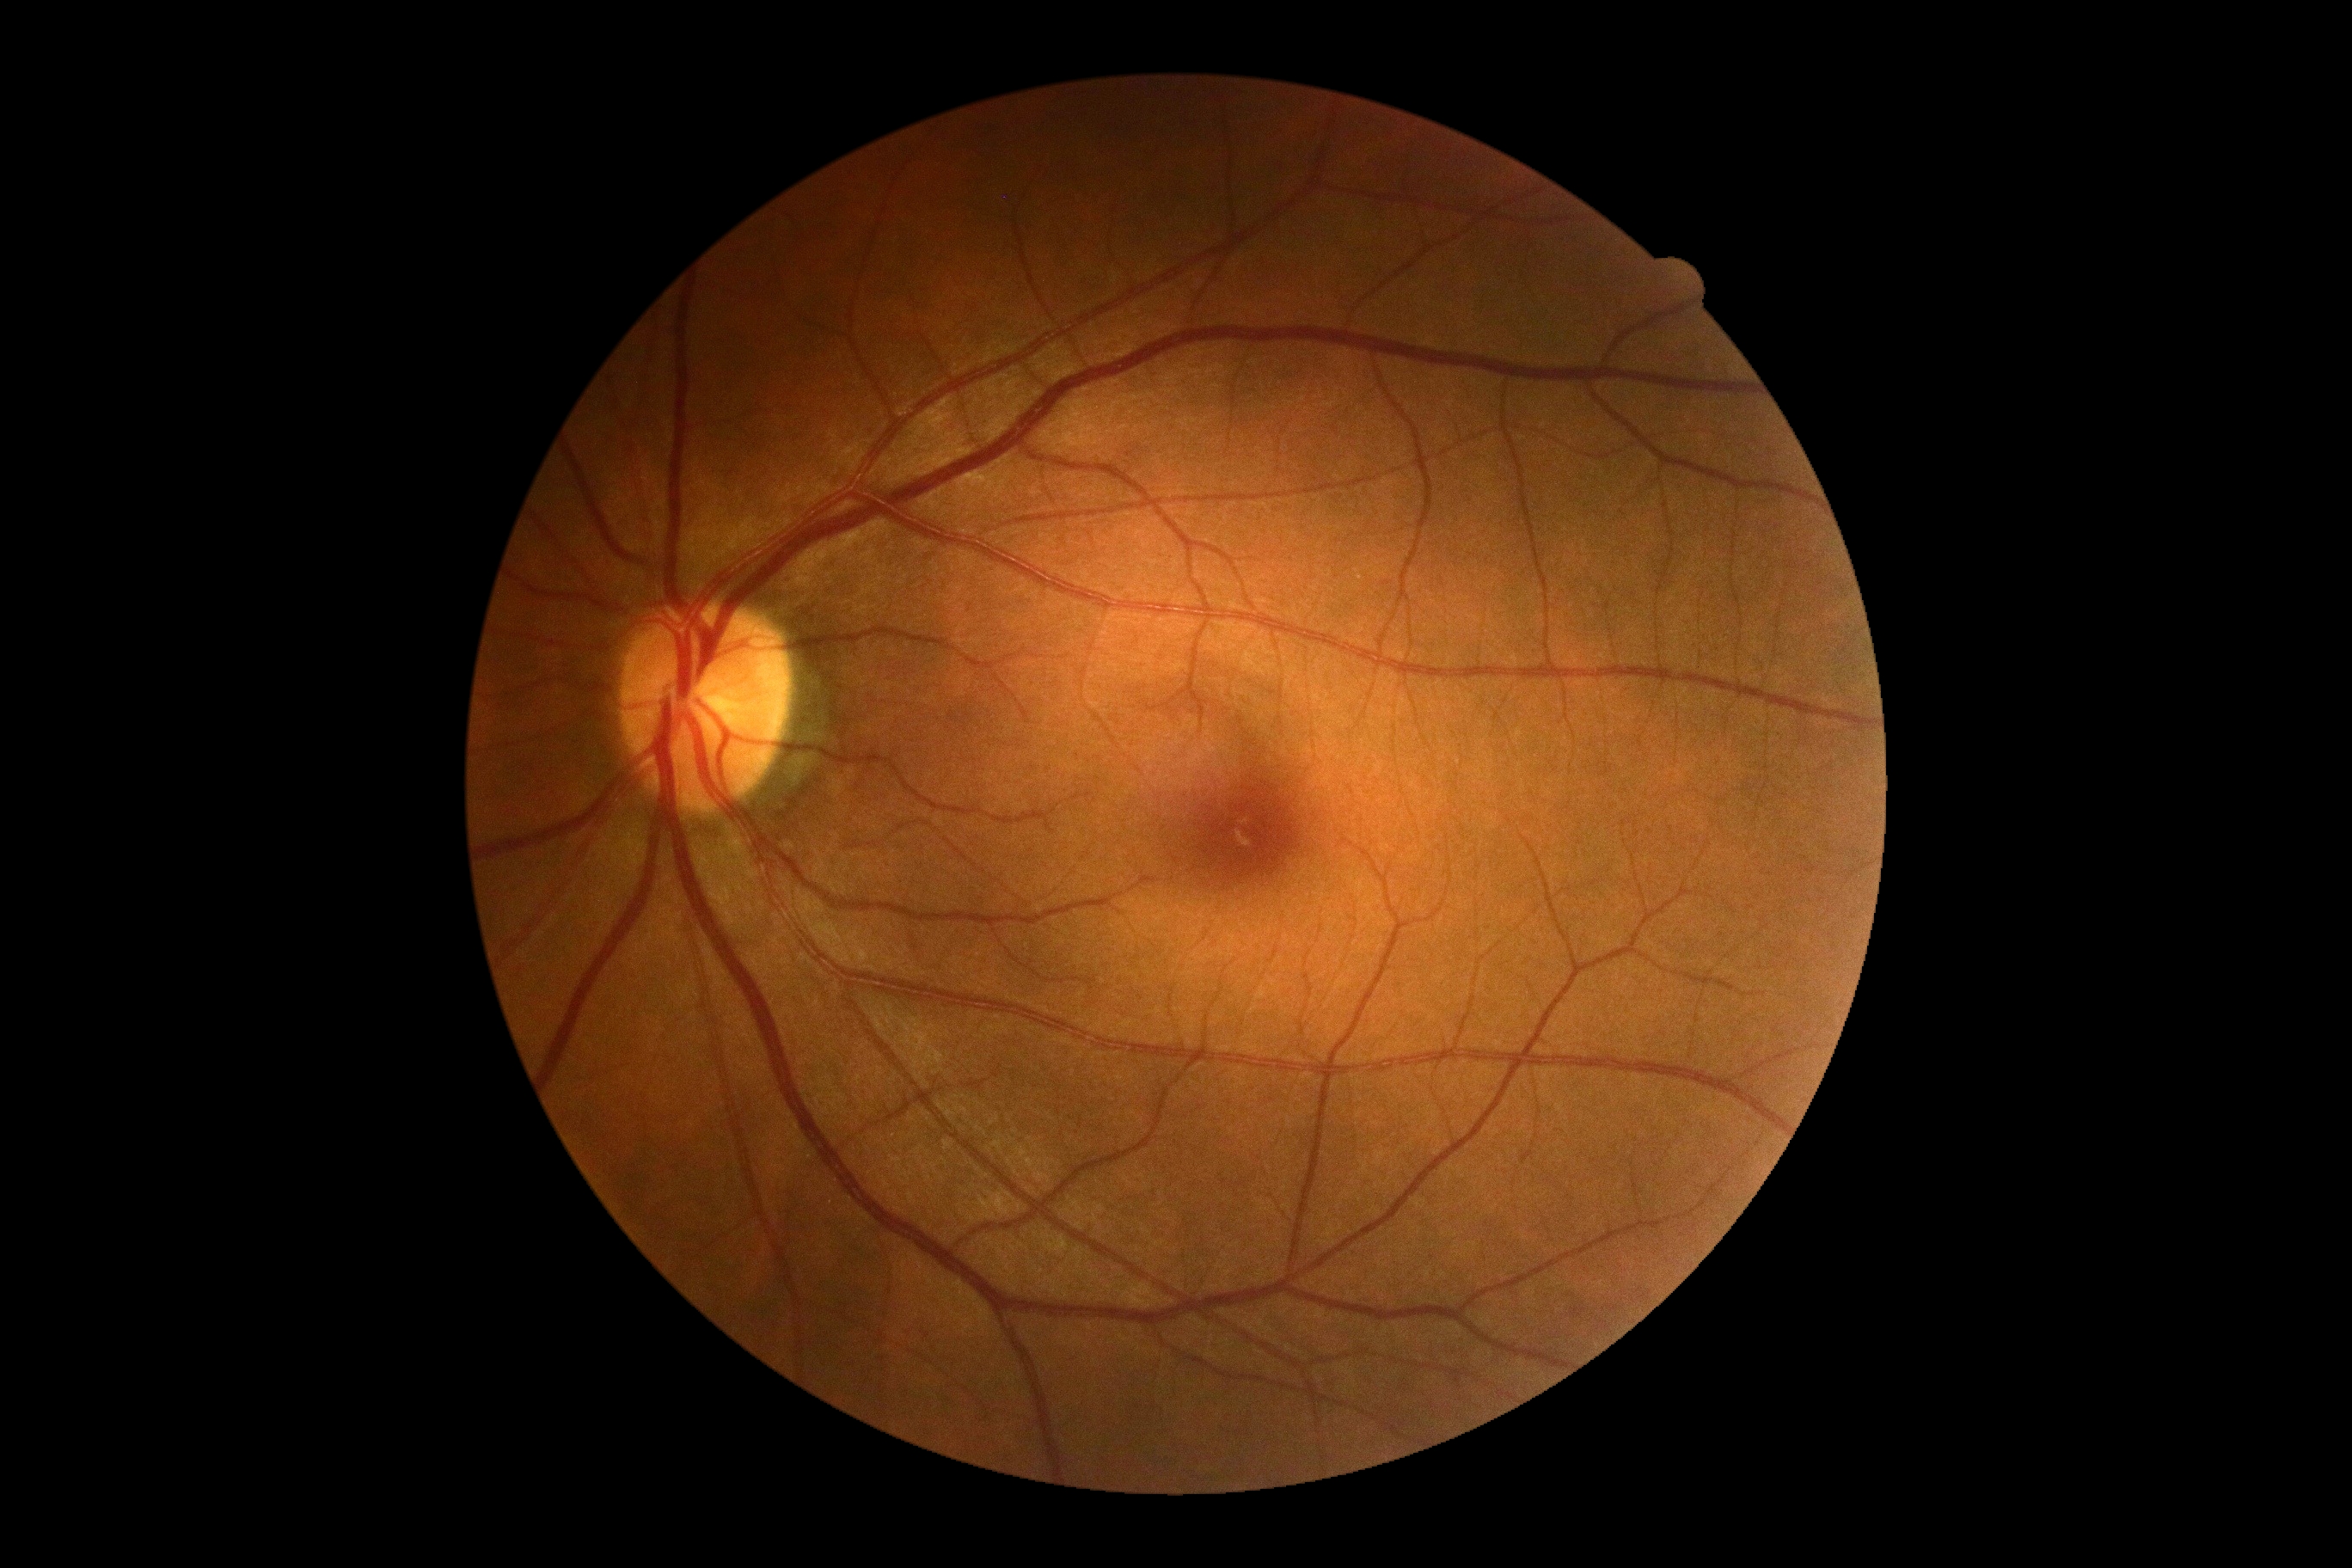

Diabetic retinopathy severity: grade 0 (no apparent retinopathy).